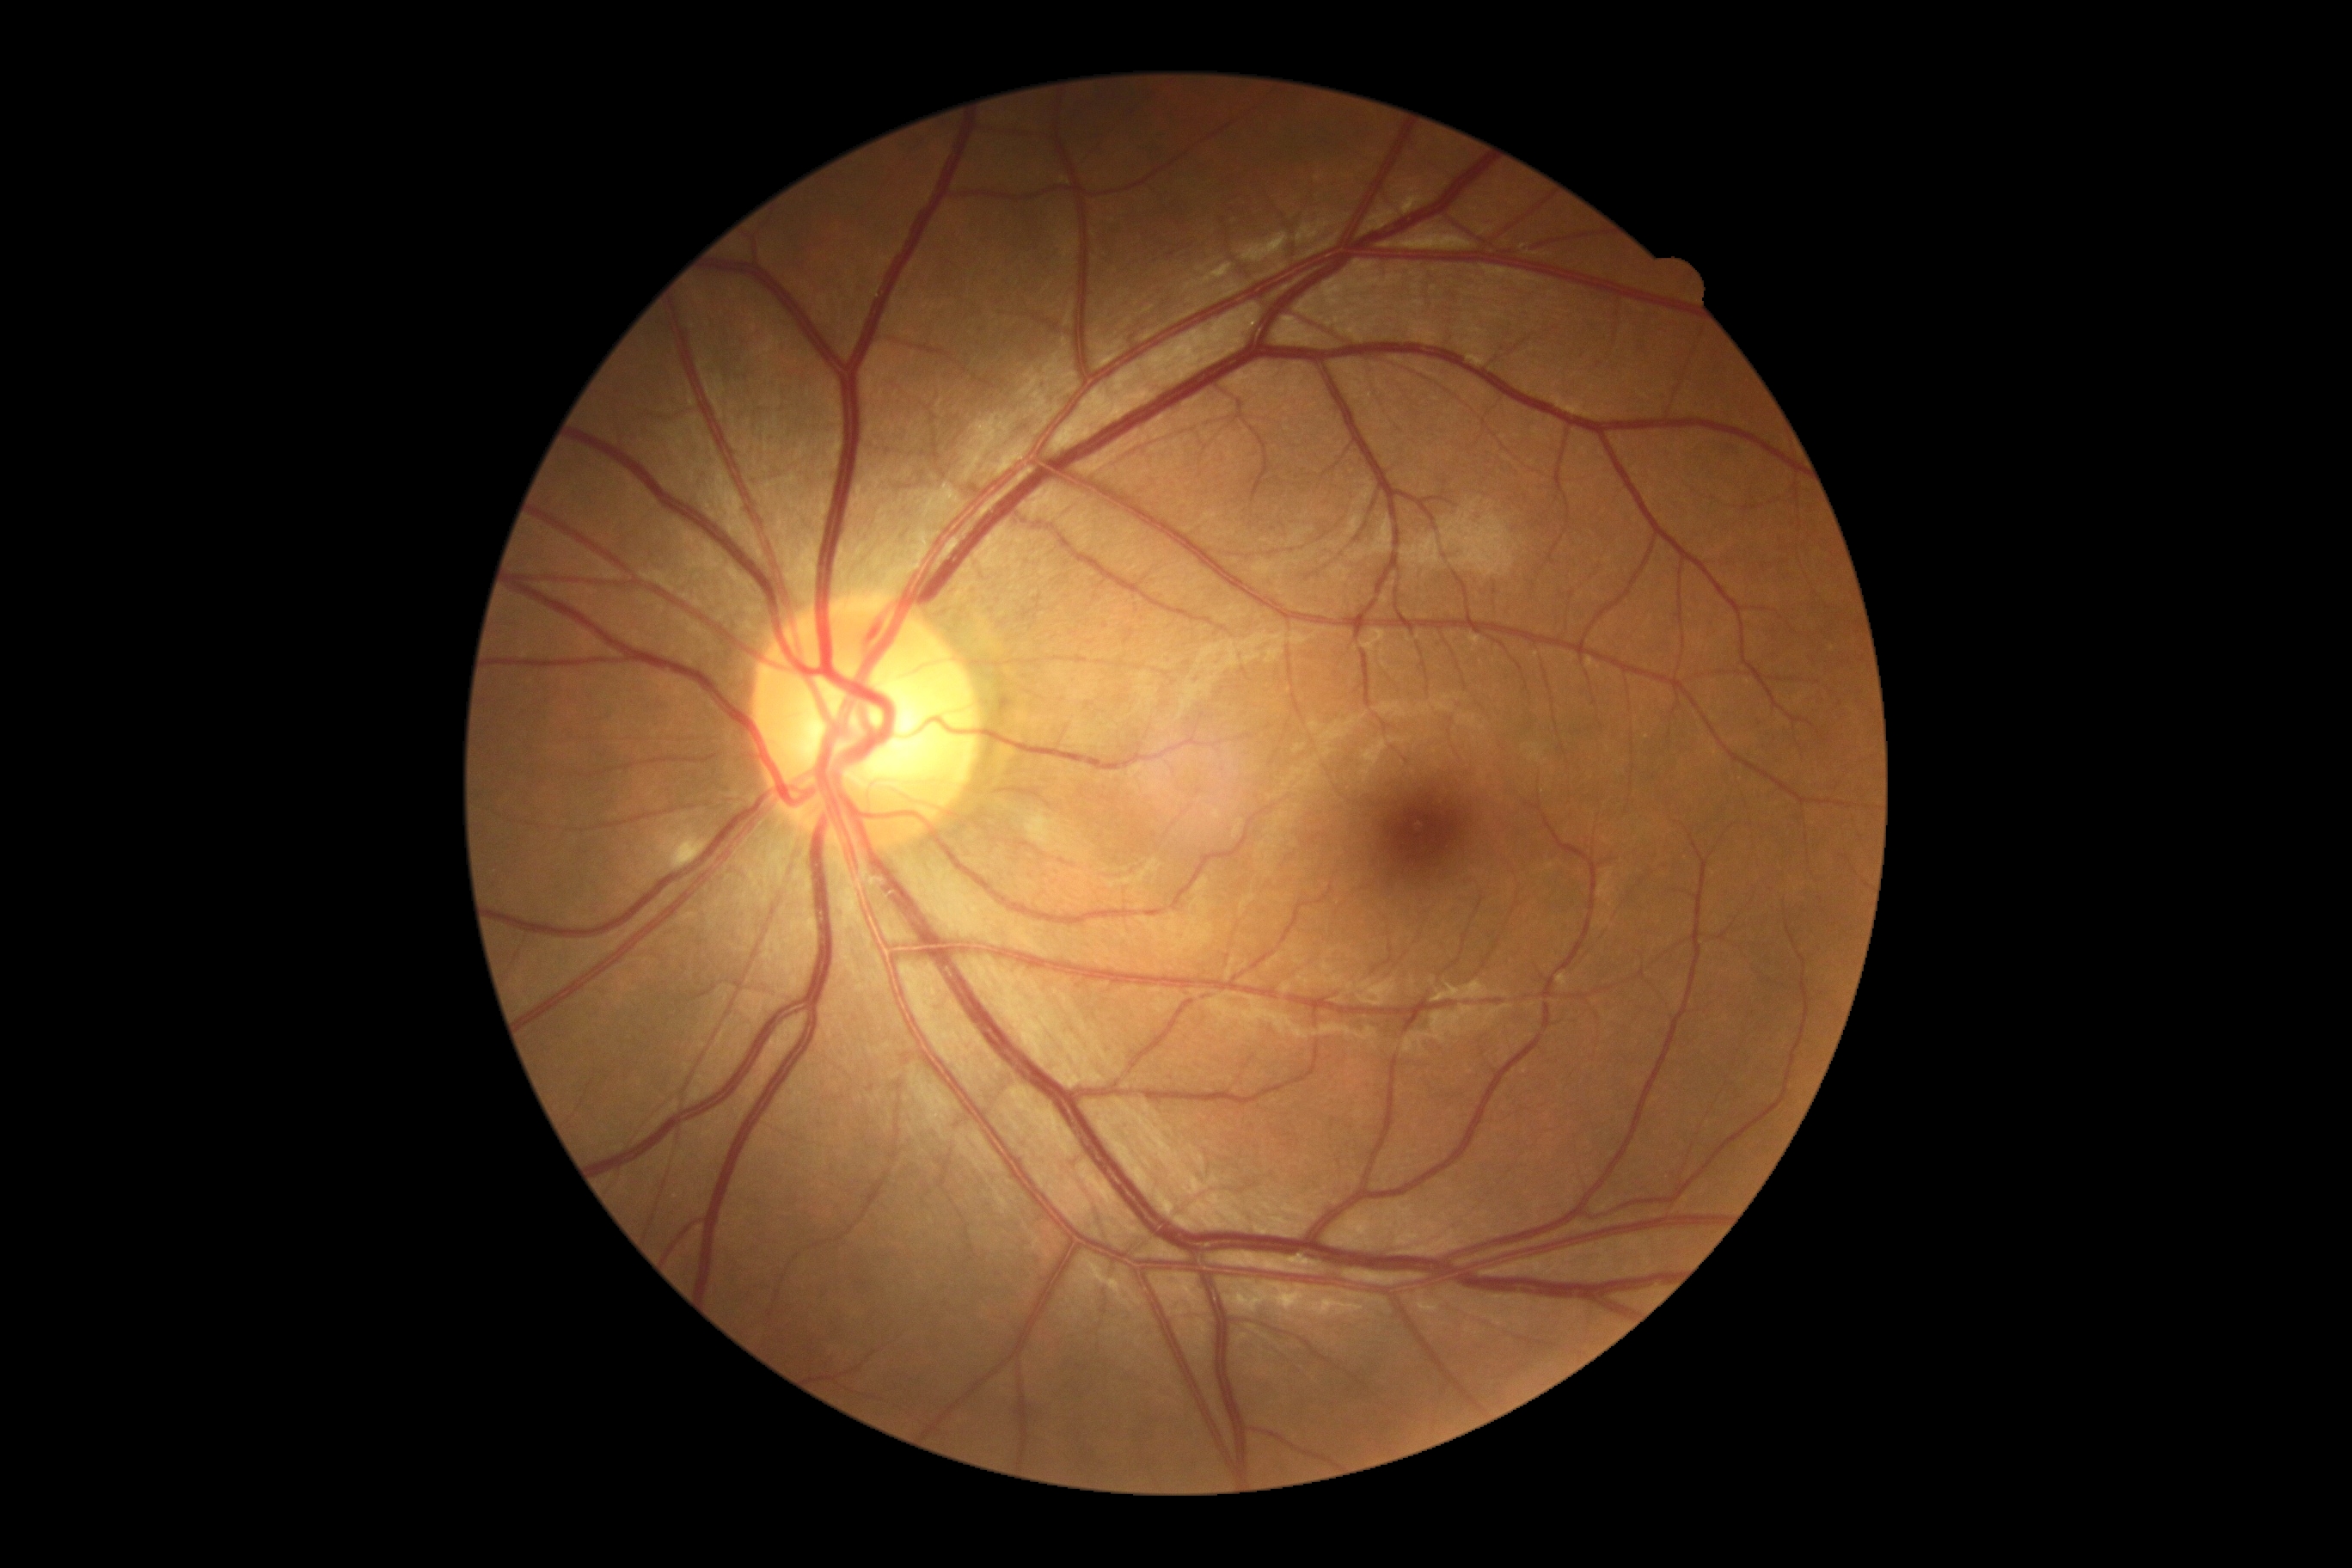
DR grade is 2.